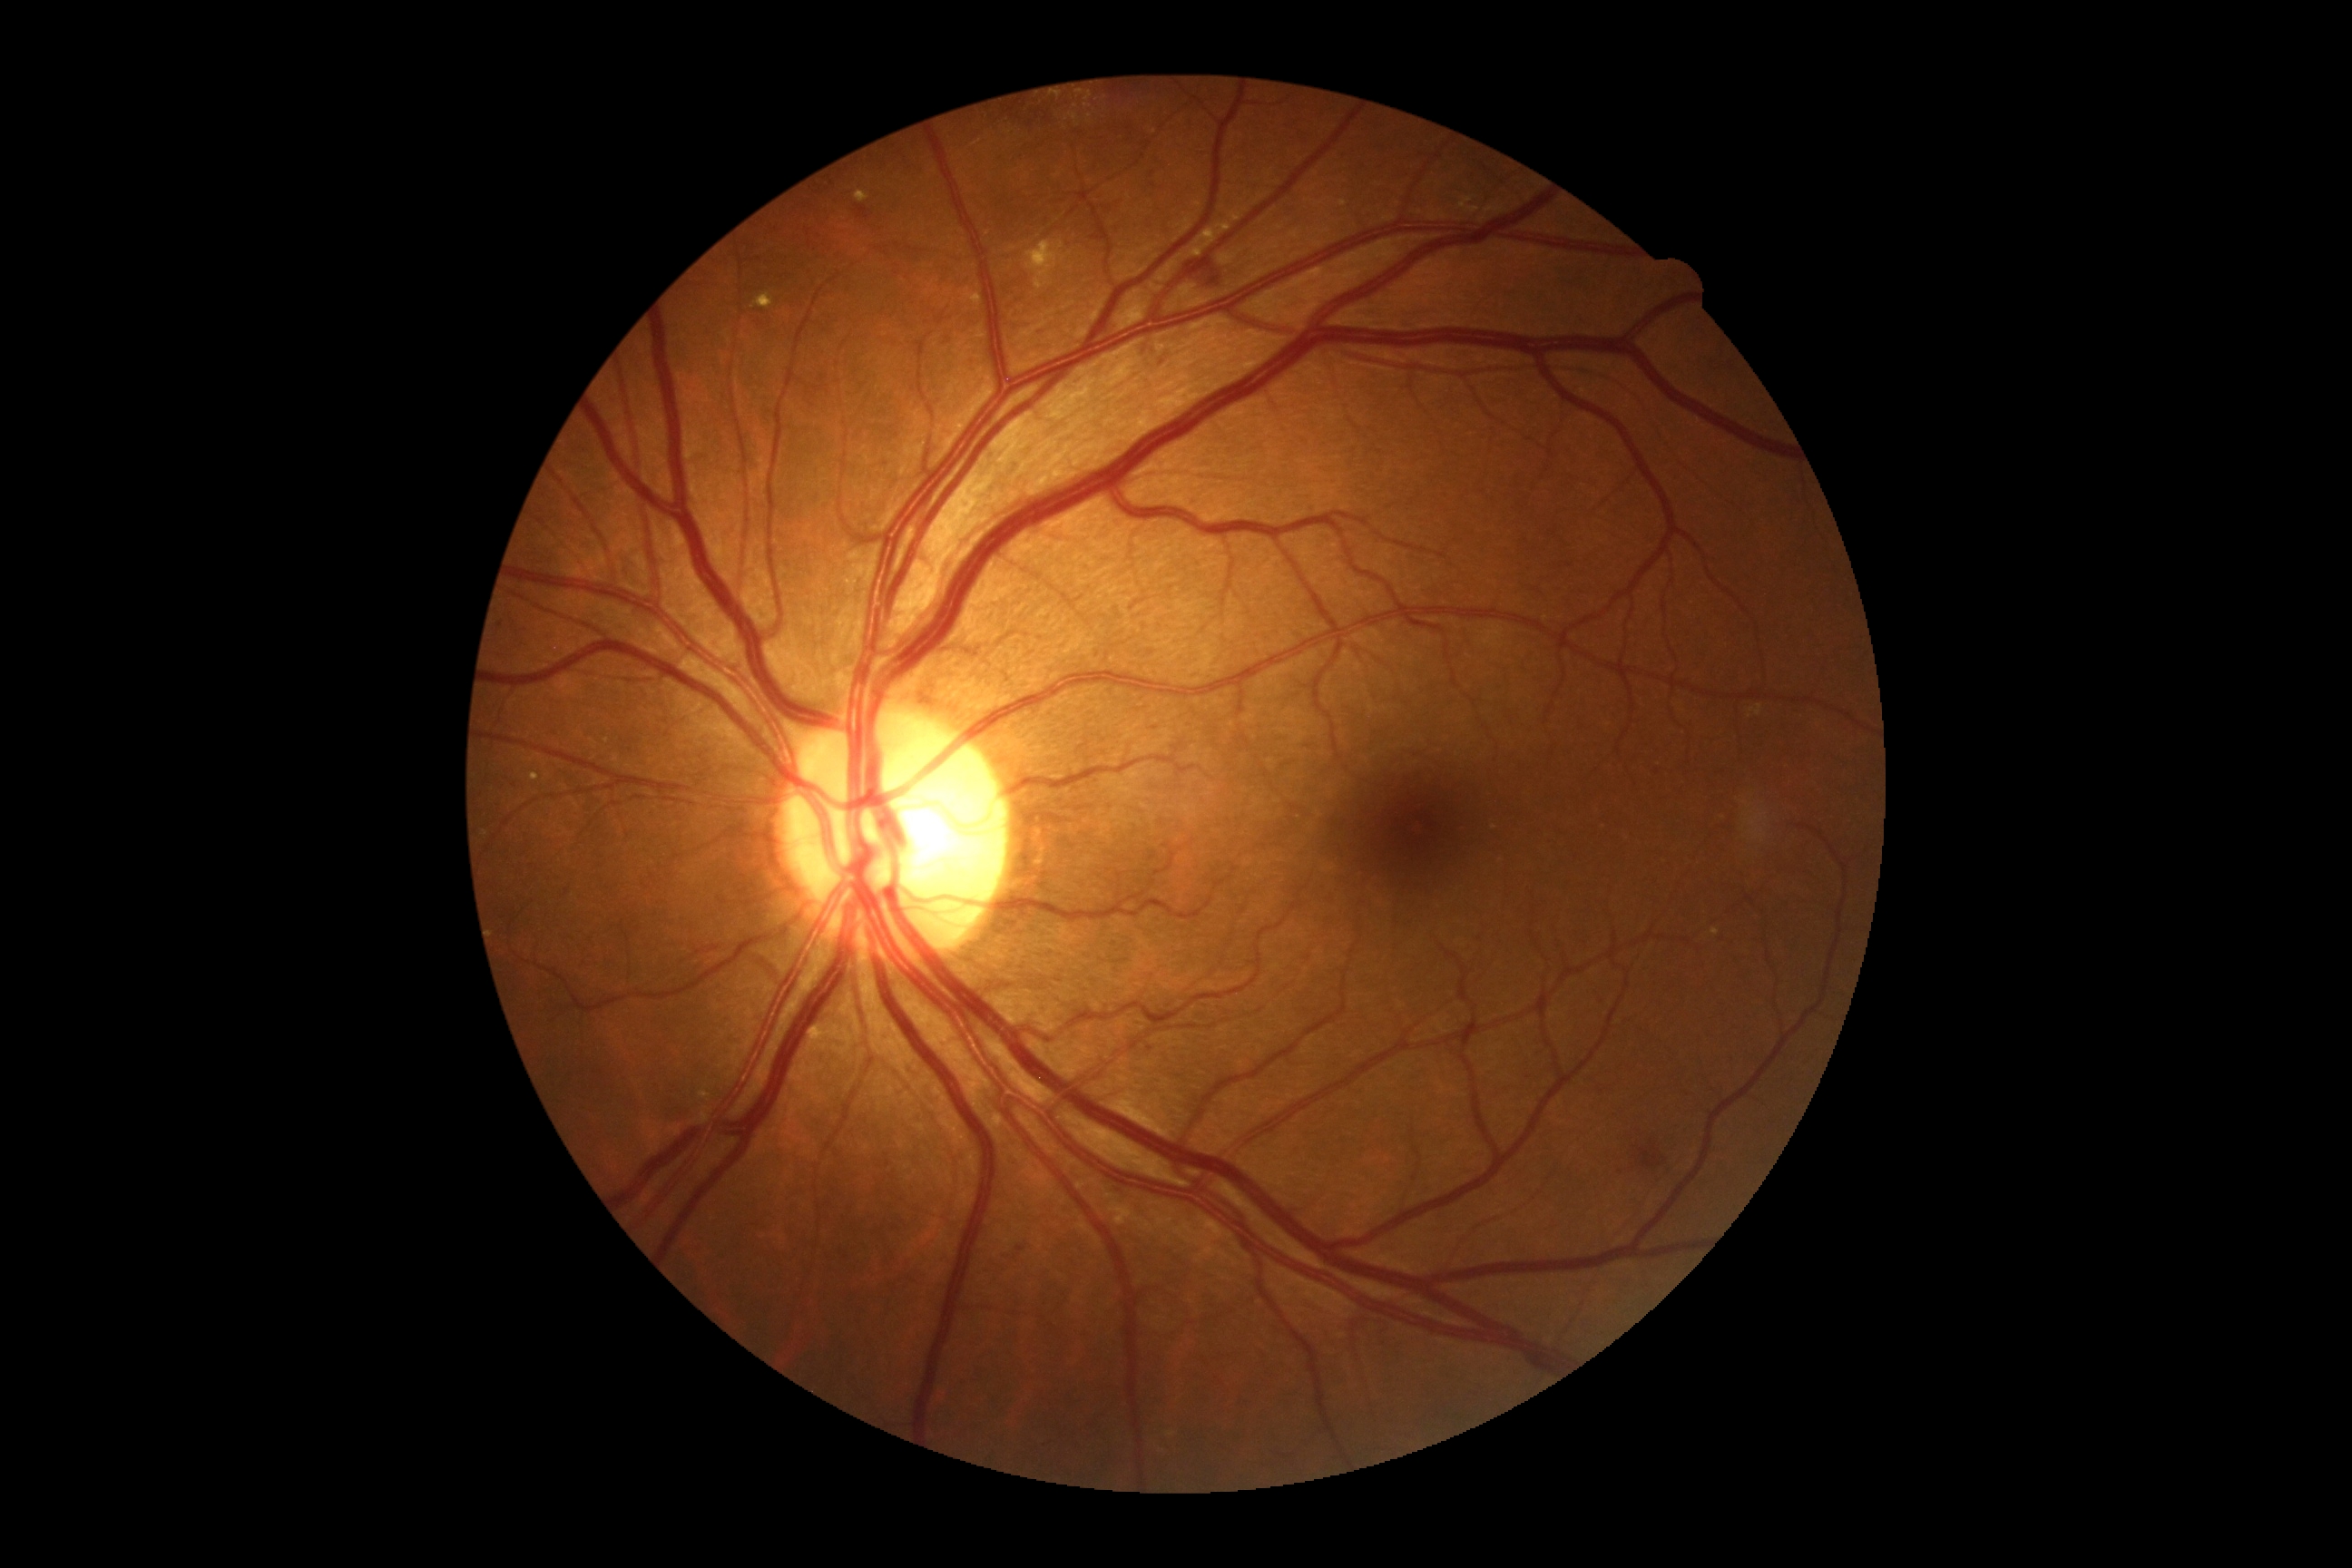 Diabetic retinopathy: 2/4
A subset of detected lesions:
soft exudates: none detected
microaneurysms: none detected
hemorrhages: Rect(1181, 260, 1222, 291) | Rect(1634, 1141, 1661, 1170) | Rect(1017, 1246, 1026, 1255)
Hemorrhages (small, approximate centers) near [885,465] | [1665,1159] | [1621,1171] | [1150,1049] | [502,625]
hard exudates (more not shown): Rect(752, 293, 774, 309) | Rect(1712, 928, 1720, 936) | Rect(1230, 210, 1246, 222) | Rect(1026, 240, 1066, 291) | Rect(1070, 113, 1079, 121) | Rect(810, 1026, 830, 1041) | Rect(854, 190, 870, 202) | Rect(531, 772, 540, 781) | Rect(1340, 201, 1348, 208) | Rect(1188, 222, 1233, 257)
Hard exudates (small, approximate centers) near [1089,98] | [1087,106]